Infant wide-field fundus photograph — 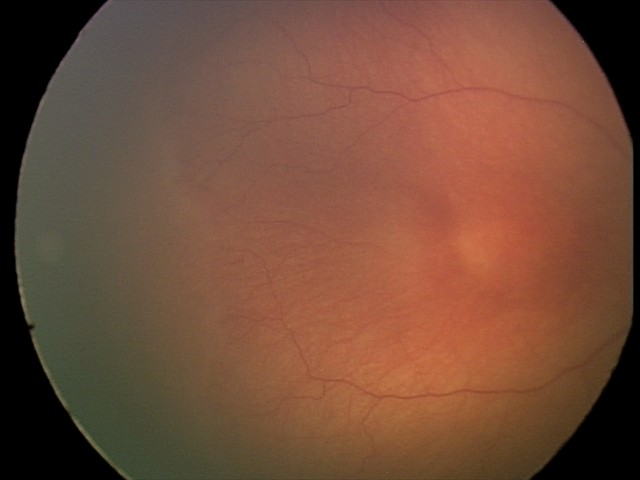

Screening diagnosis: retinopathy of prematurity (ROP) stage 1
plus disease: absent